Infant wide-field fundus photograph
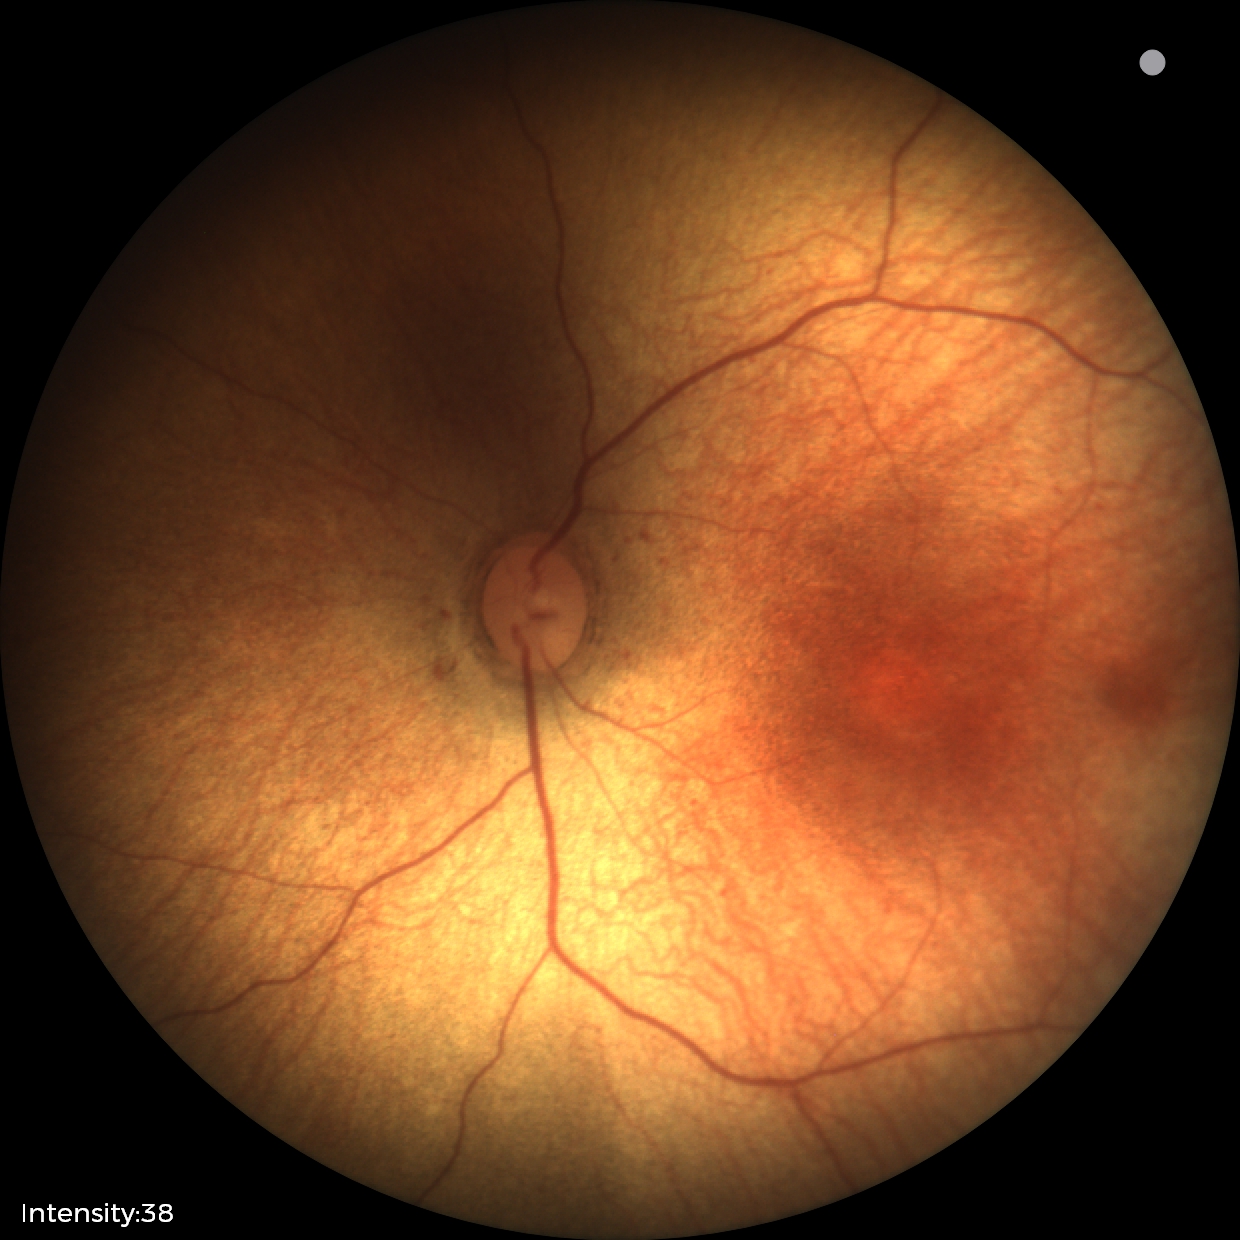 Screening examination diagnosed as physiological.